RetCam wide-field infant fundus image; 1440x1080px
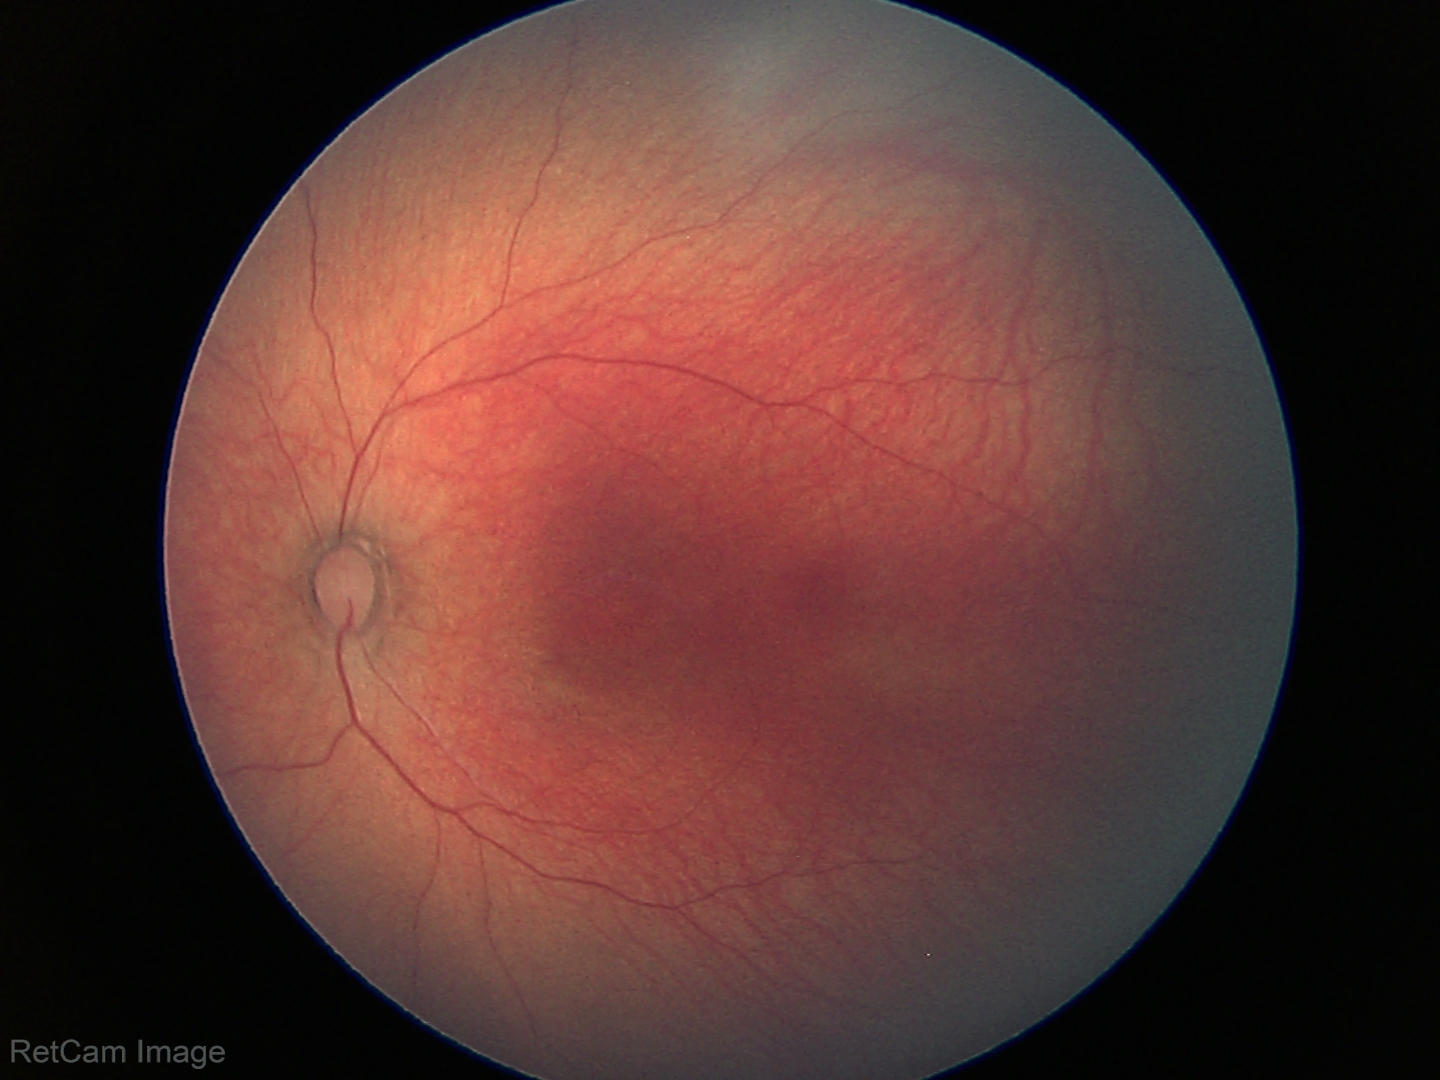

Normal screening examination.